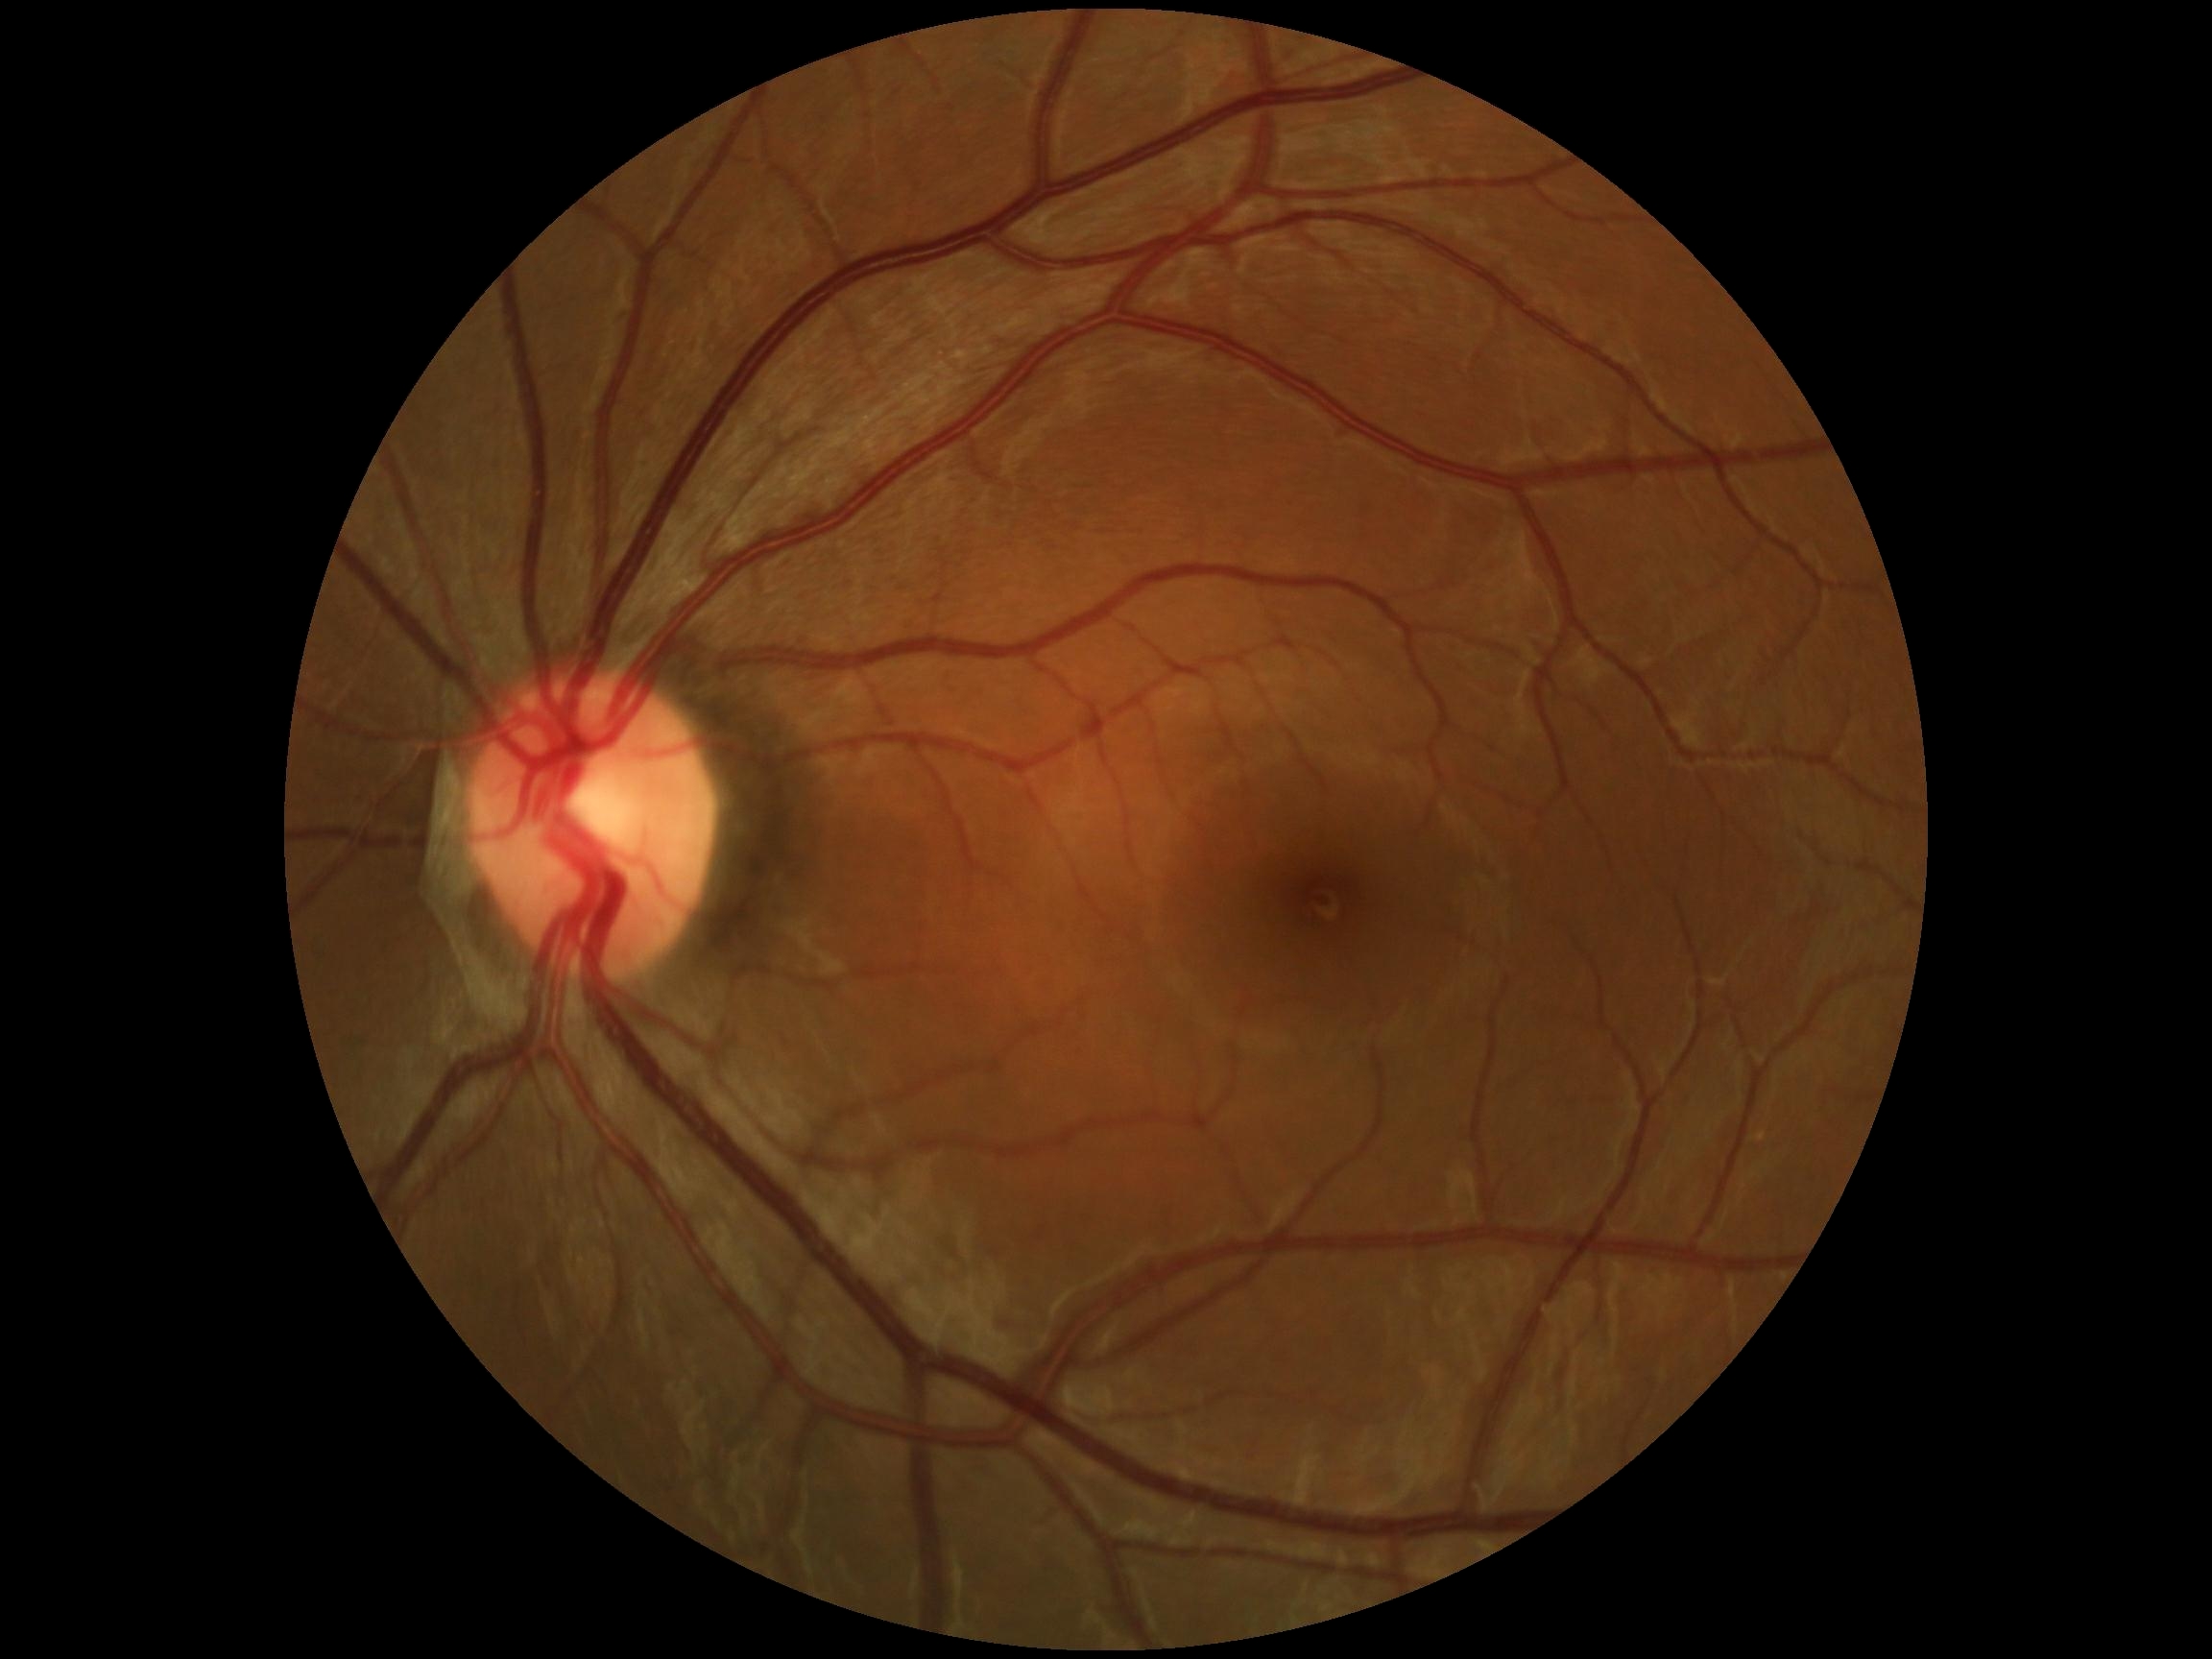 DR grade: no apparent diabetic retinopathy (0) — no visible signs of diabetic retinopathy.